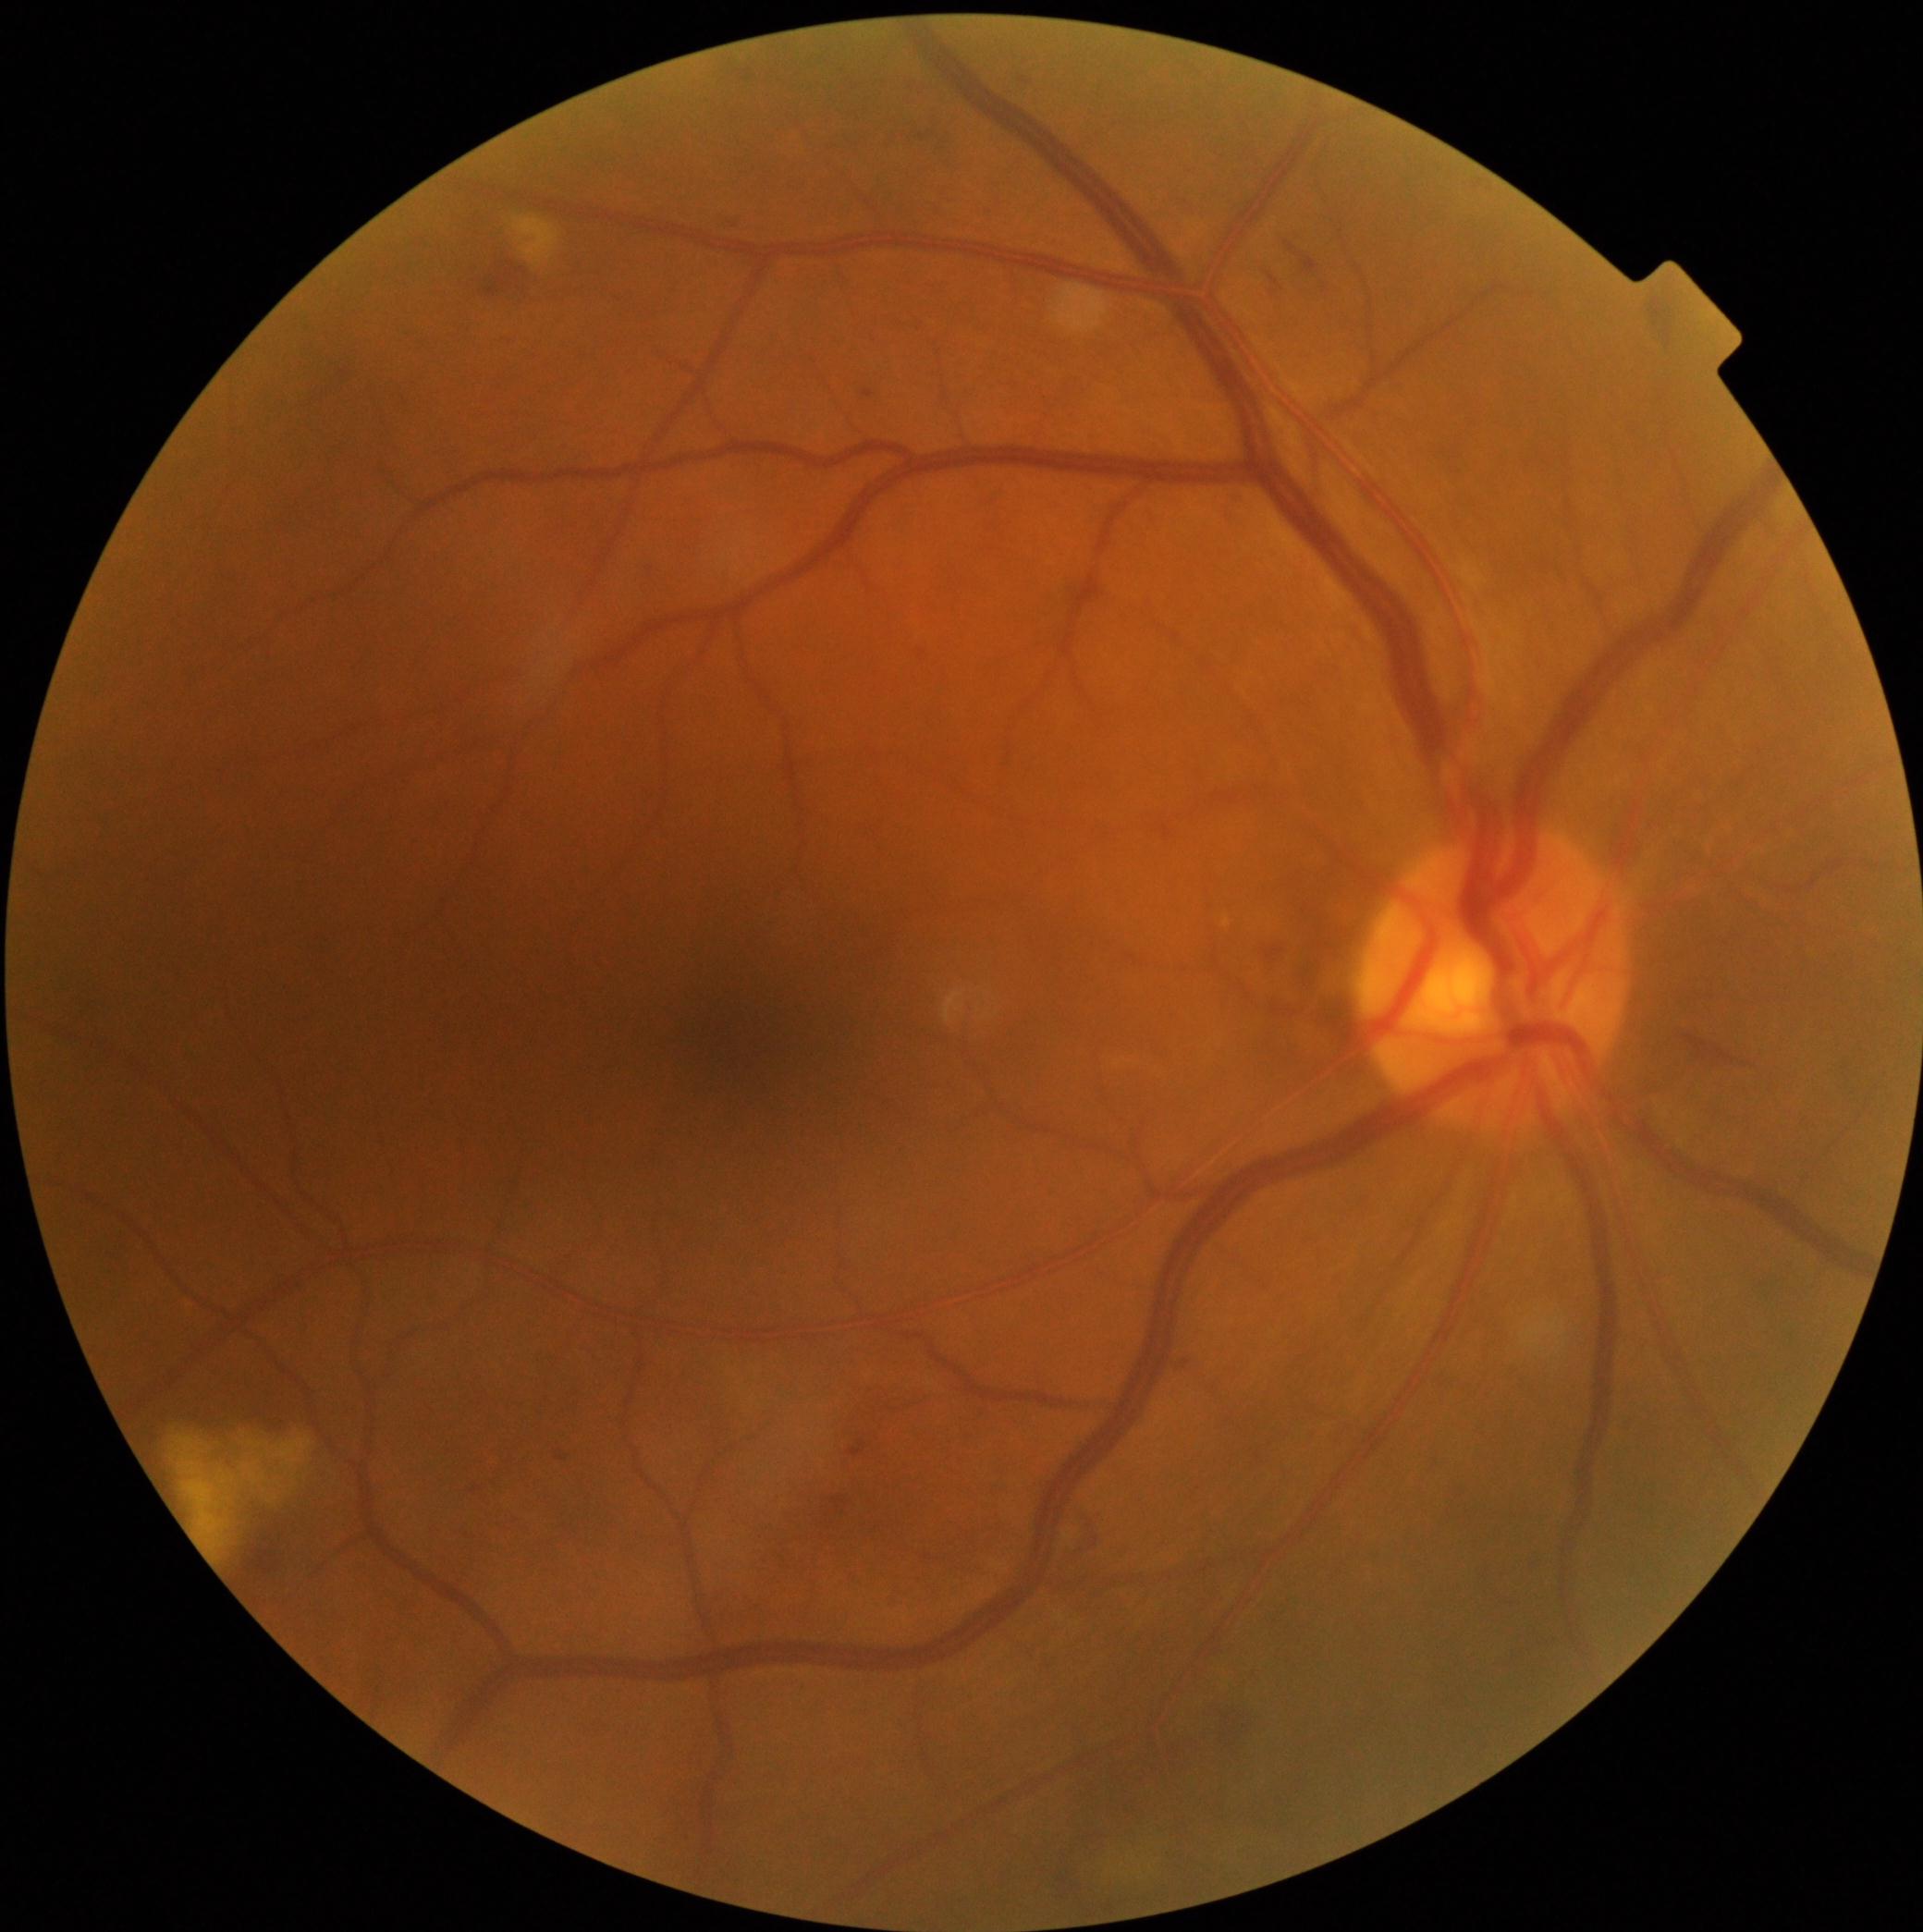

retinopathy grade = moderate non-proliferative diabetic retinopathy (2).